Modified Davis classification, nonmydriatic fundus photograph, camera: NIDEK AFC-230:
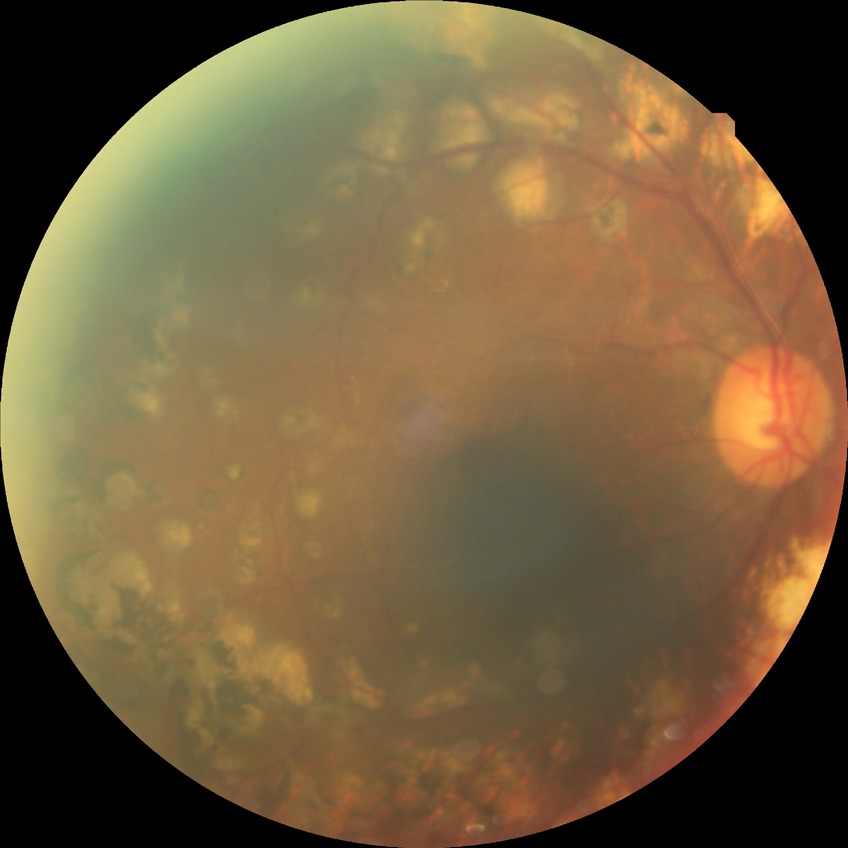
Diabetic retinopathy (DR) is PDR (proliferative diabetic retinopathy).